2048 x 1536 pixels; FOV: 45 degrees: 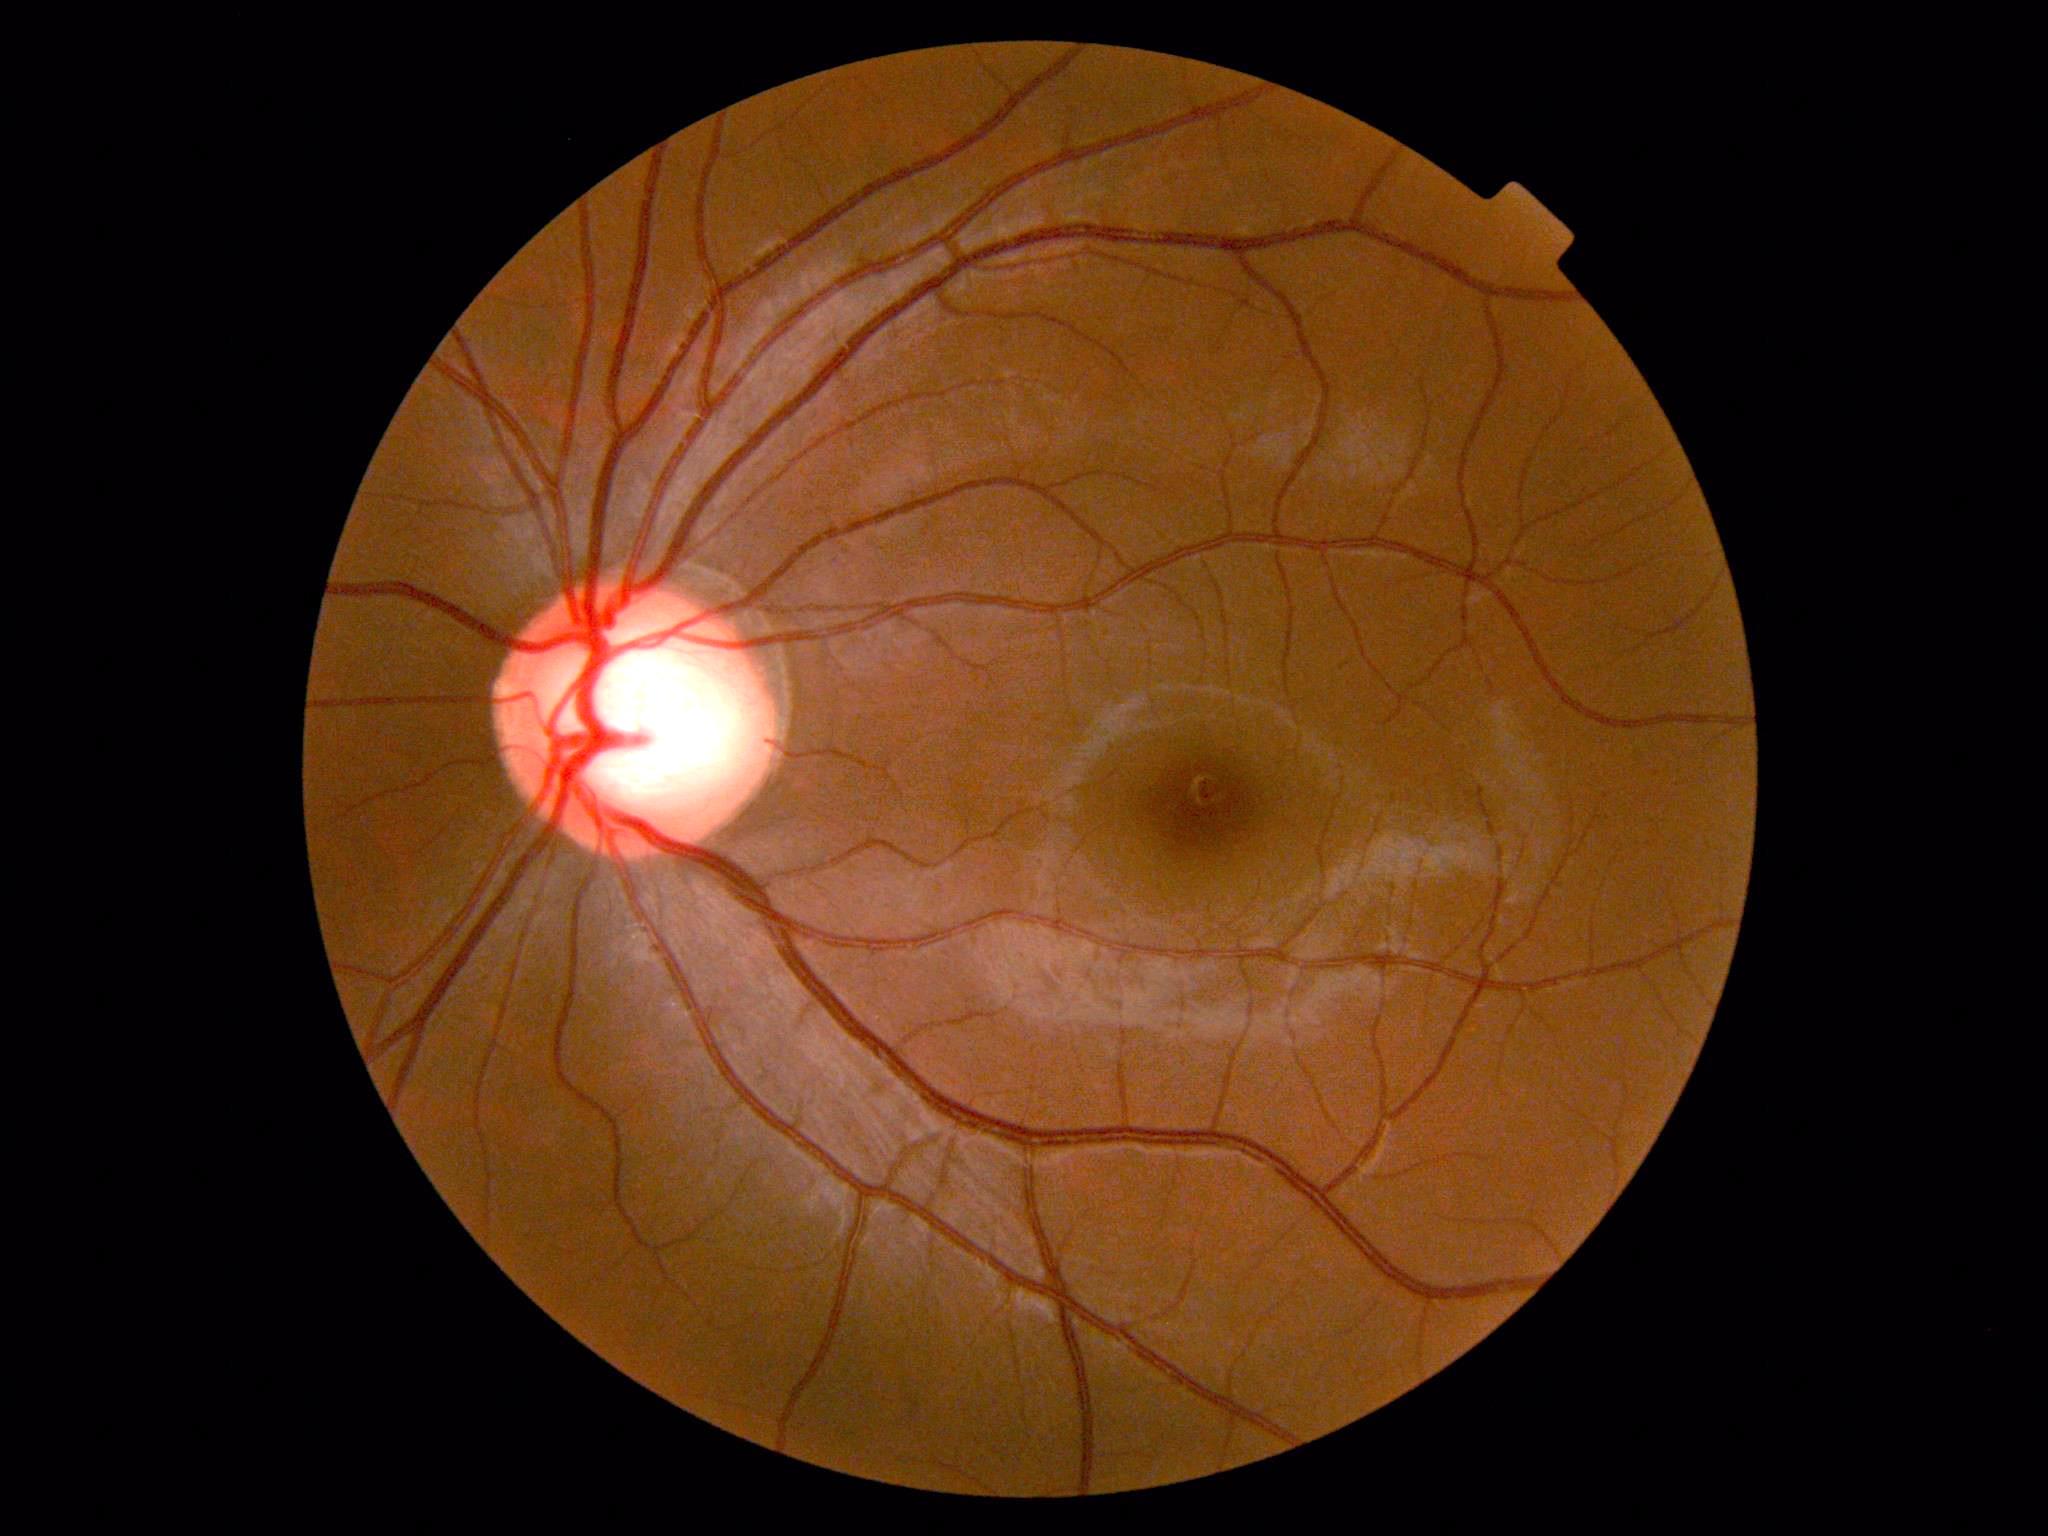

retinopathy: grade 0 (no apparent retinopathy)